Wide-field contact fundus photograph of an infant: 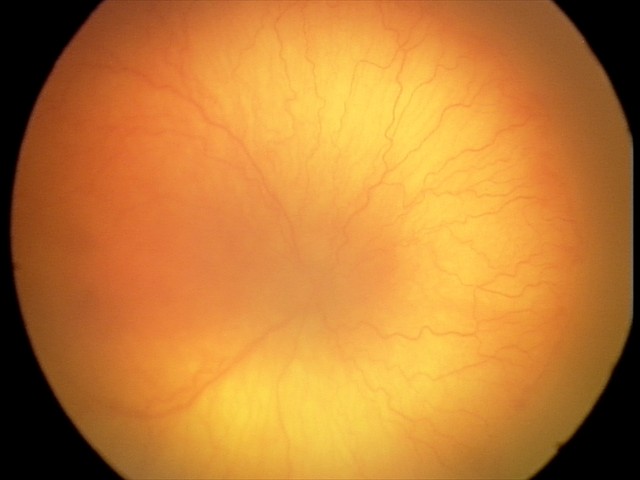
Series diagnosed as aggressive ROP (A-ROP).
With plus disease.